640 by 480 pixels. Clarity RetCam 3, 130° FOV. Wide-field fundus photograph of an infant:
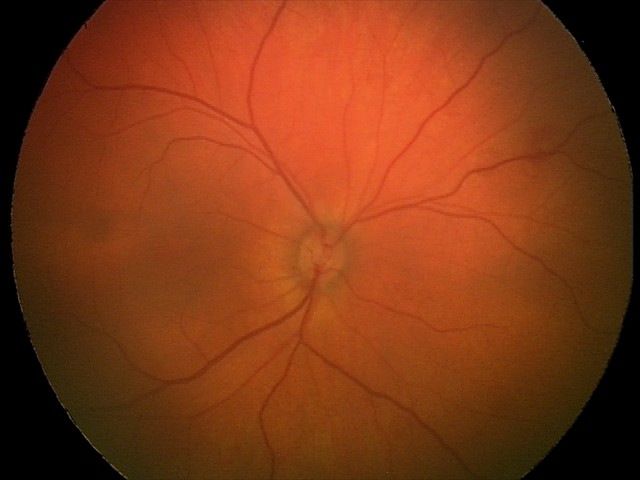

Screening diagnosis: retinal hemorrhages.